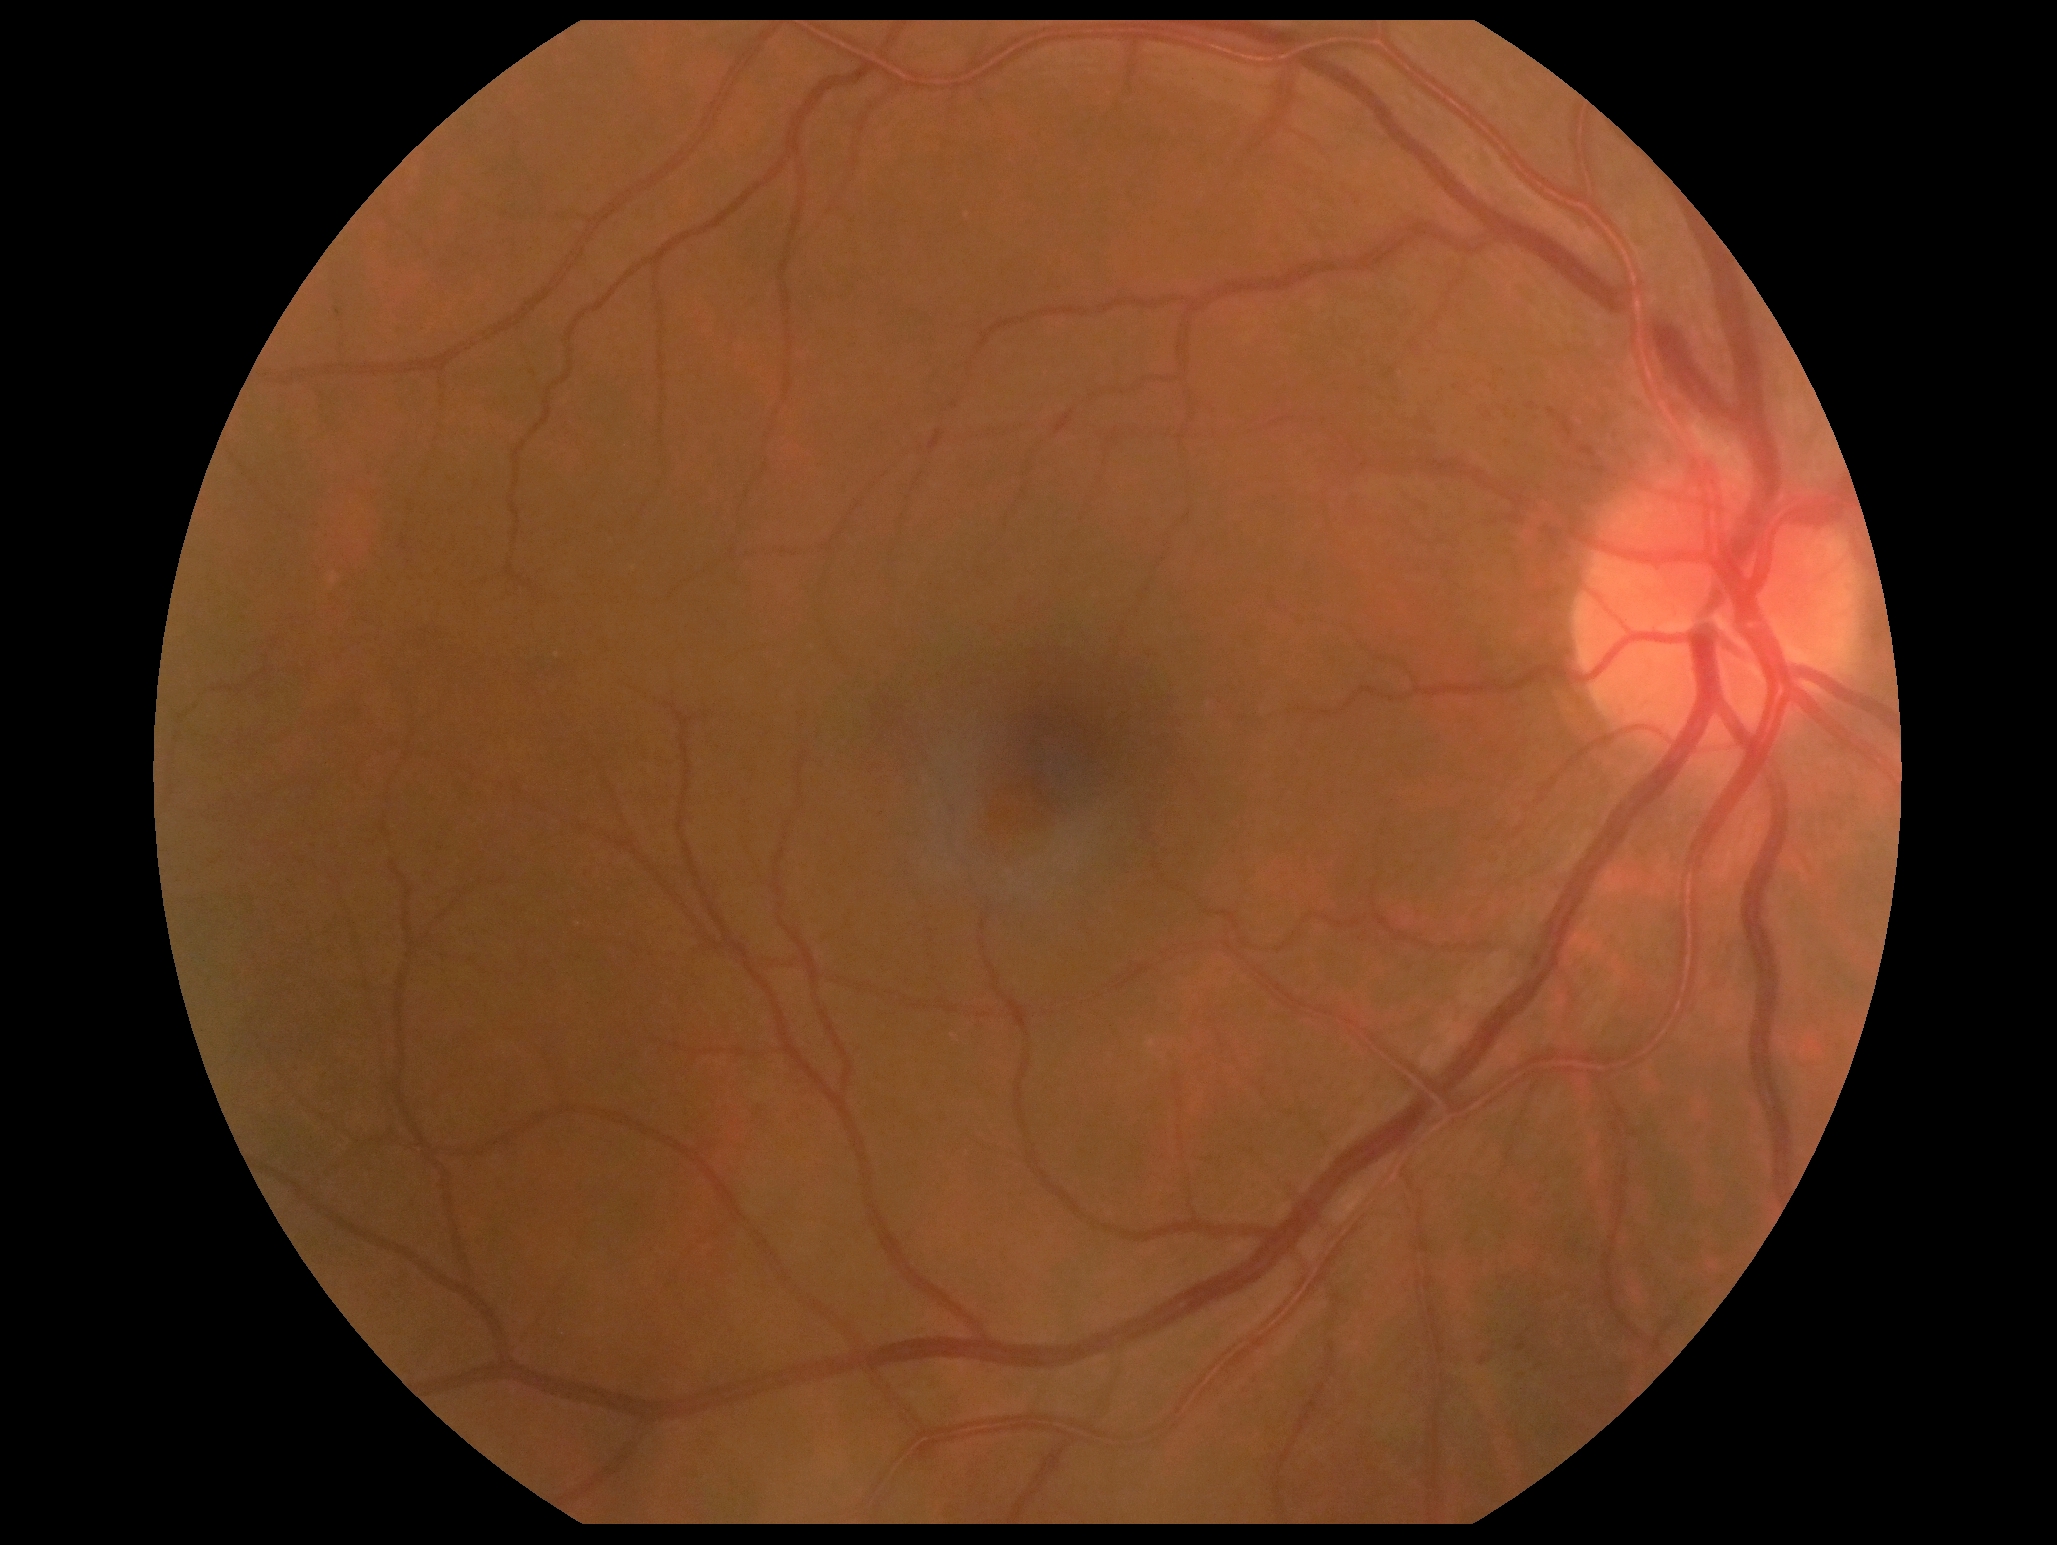
{"dr_grade": "mild NPDR (1)"}